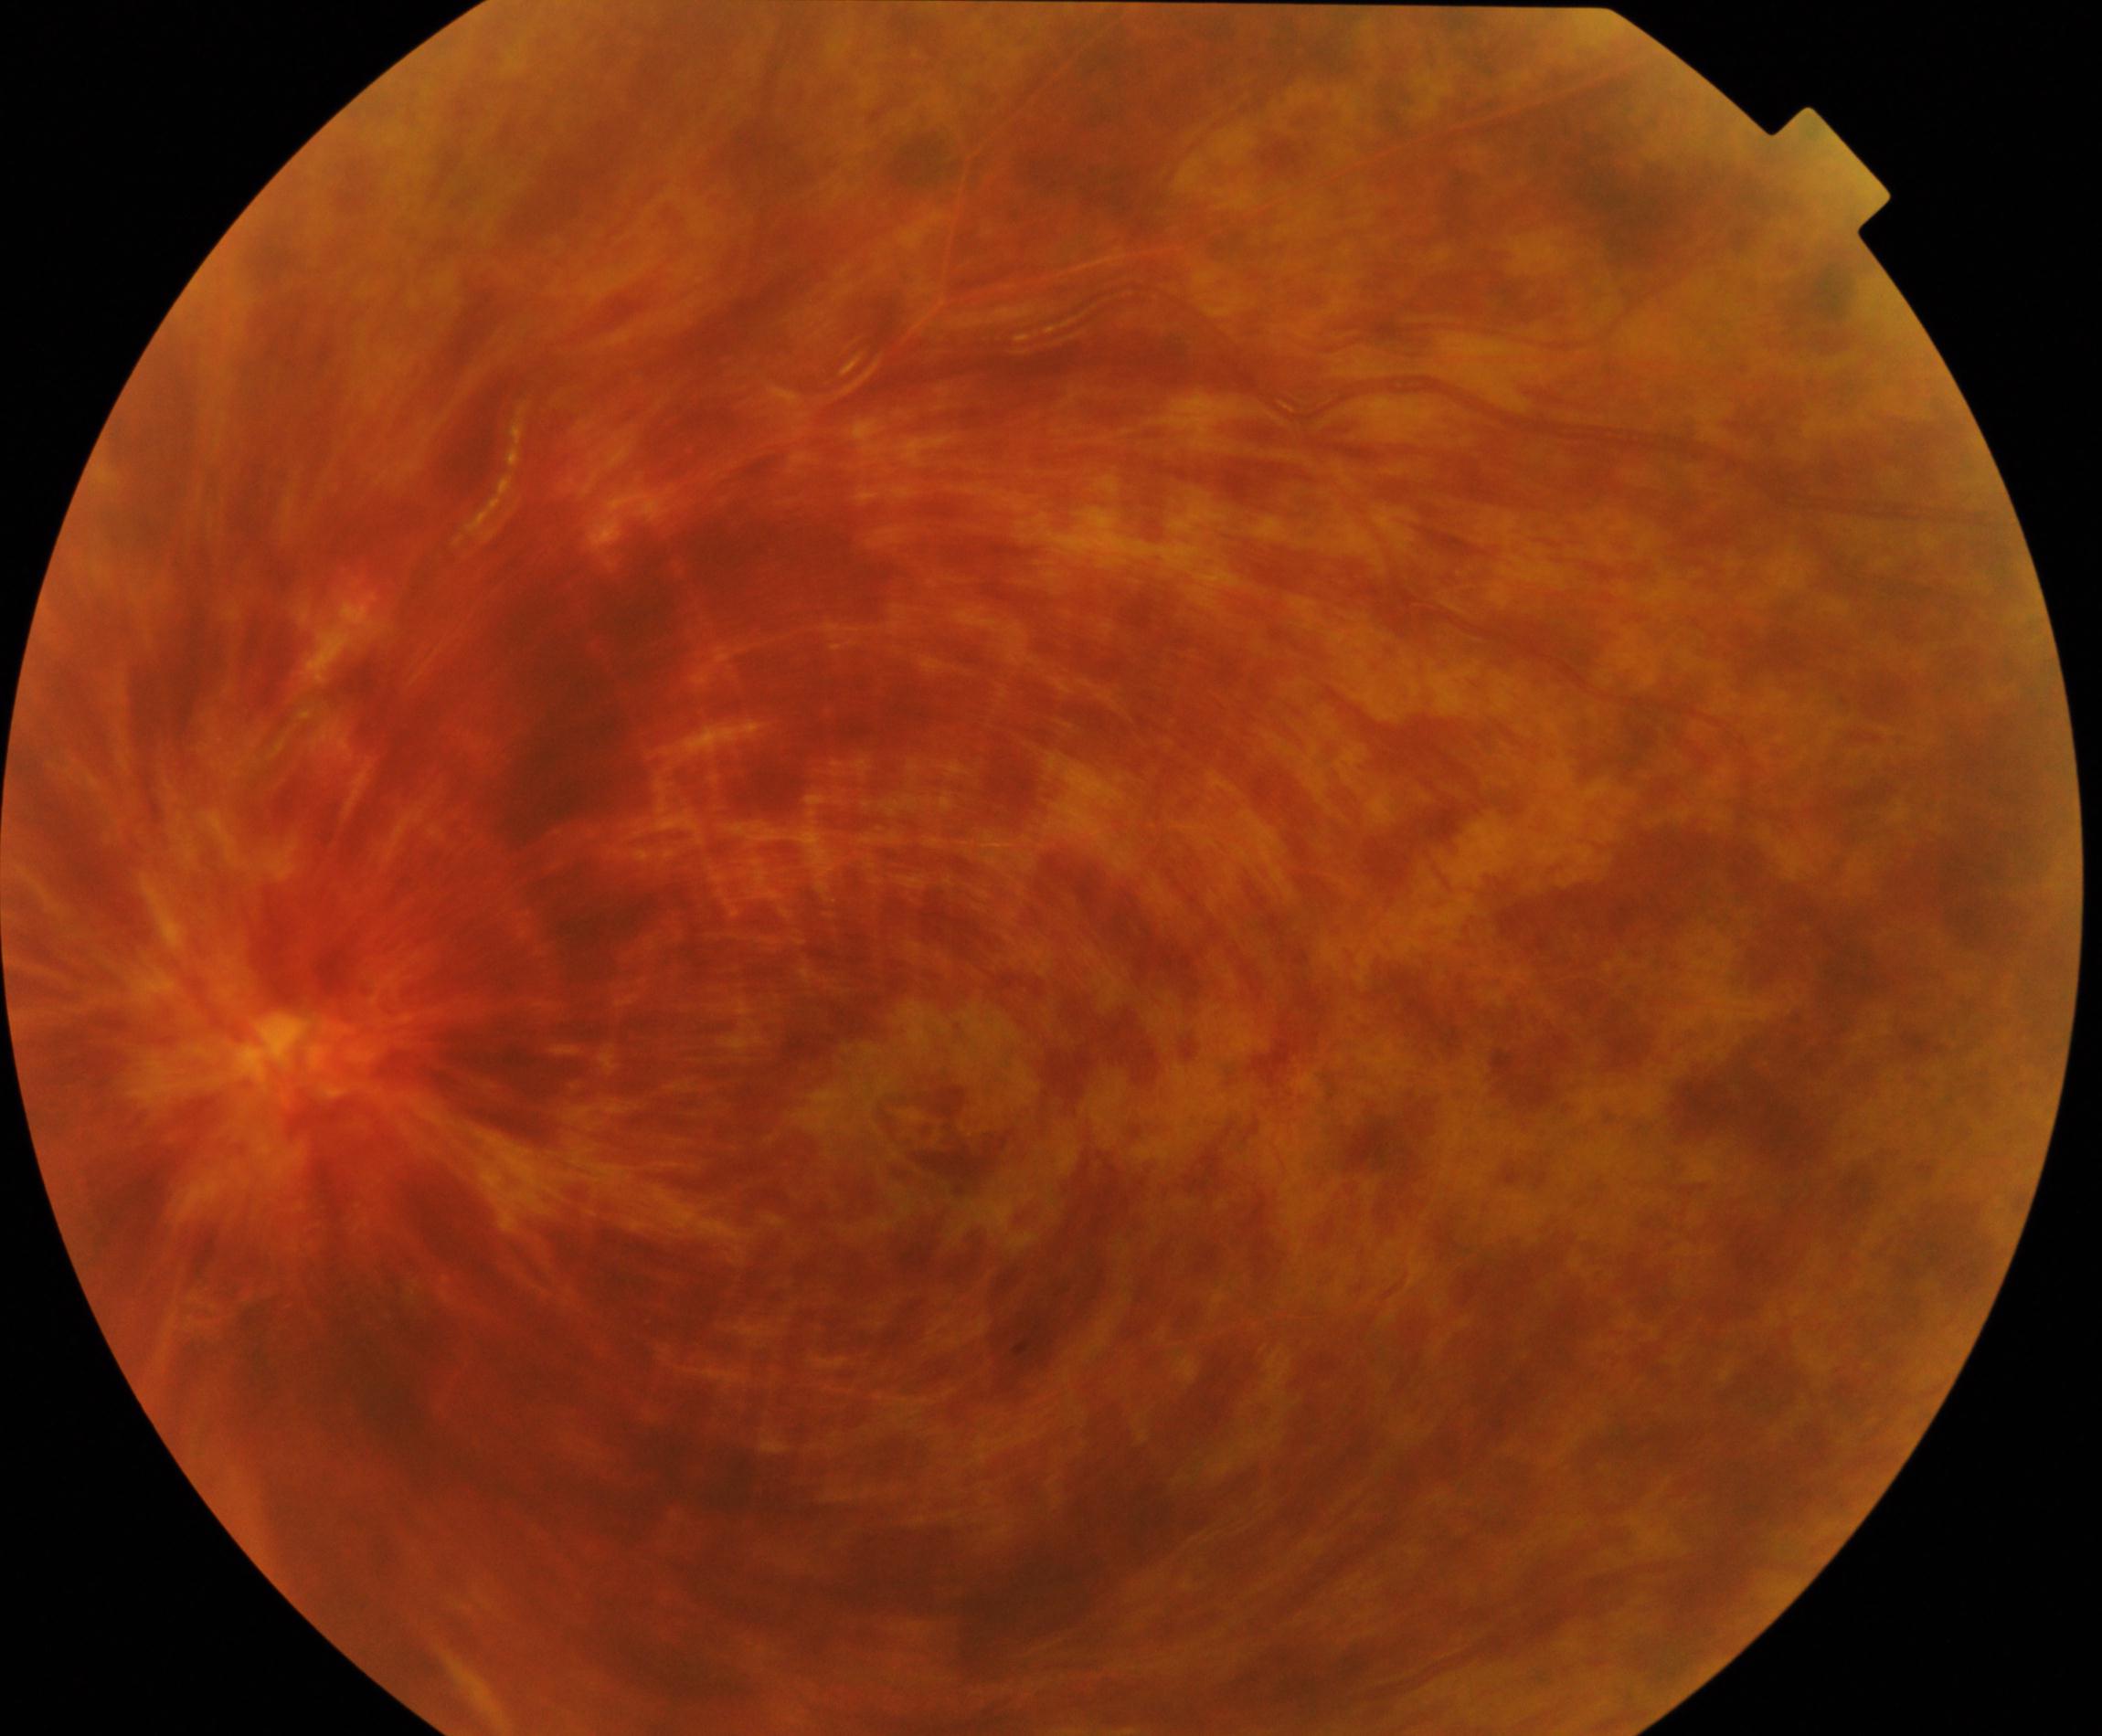 Diagnosis: central retinal vein occlusion.